Pediatric retinal photograph (wide-field) · 640x480
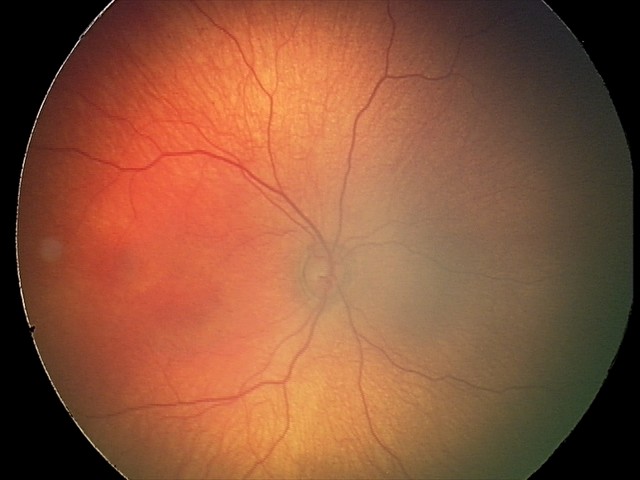 Physiological retinal appearance for postconceptual age.